45° field of view; camera: NIDEK AFC-230; fundus photo.
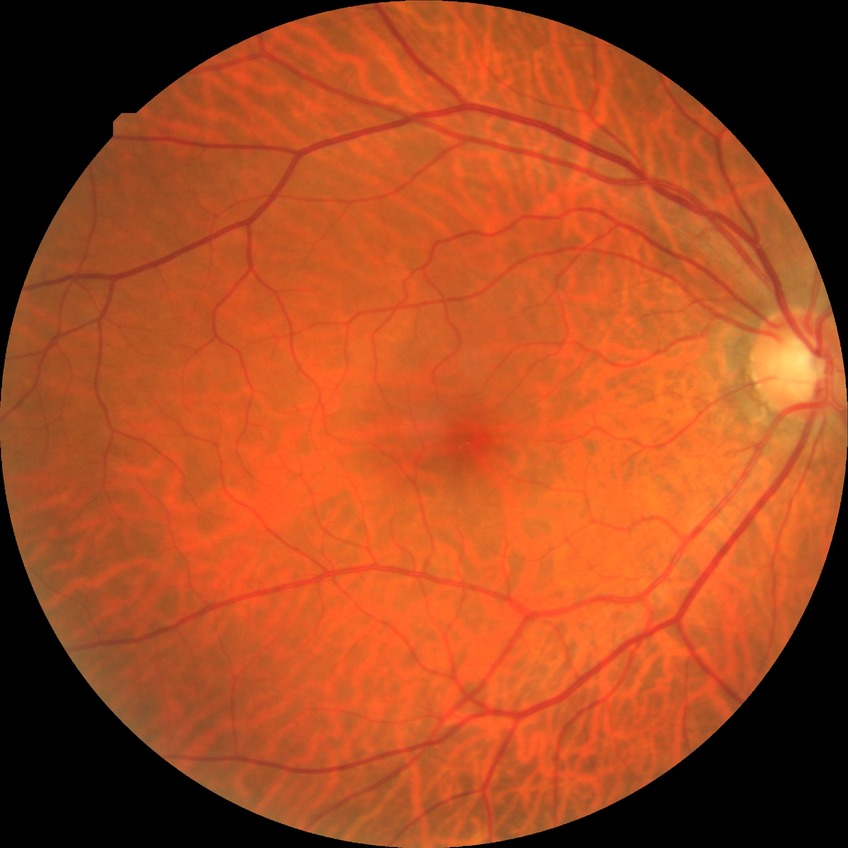
Diabetic retinopathy (DR) is NDR (no diabetic retinopathy).